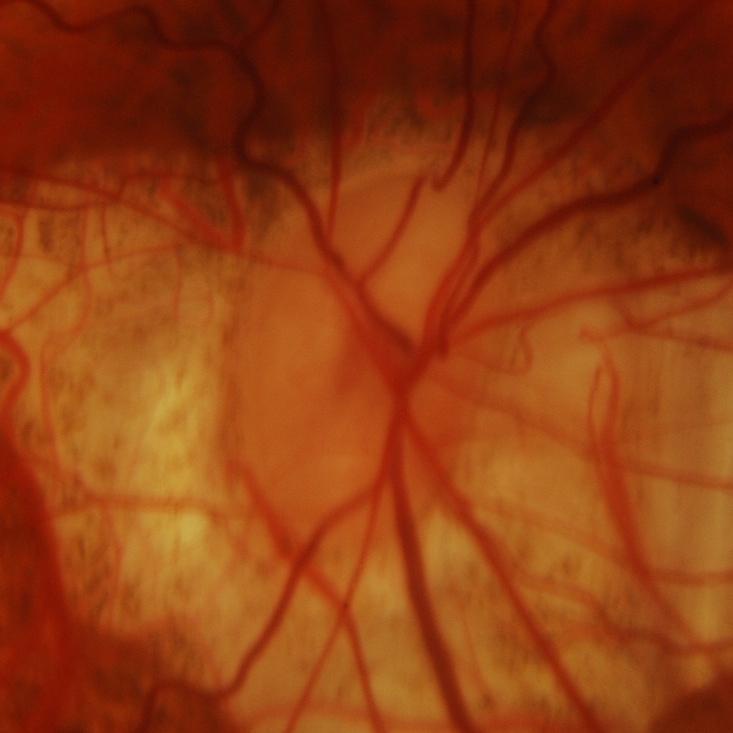
Glaucoma is present. ONH-centered fundus image showing glaucomatous optic neuropathy.